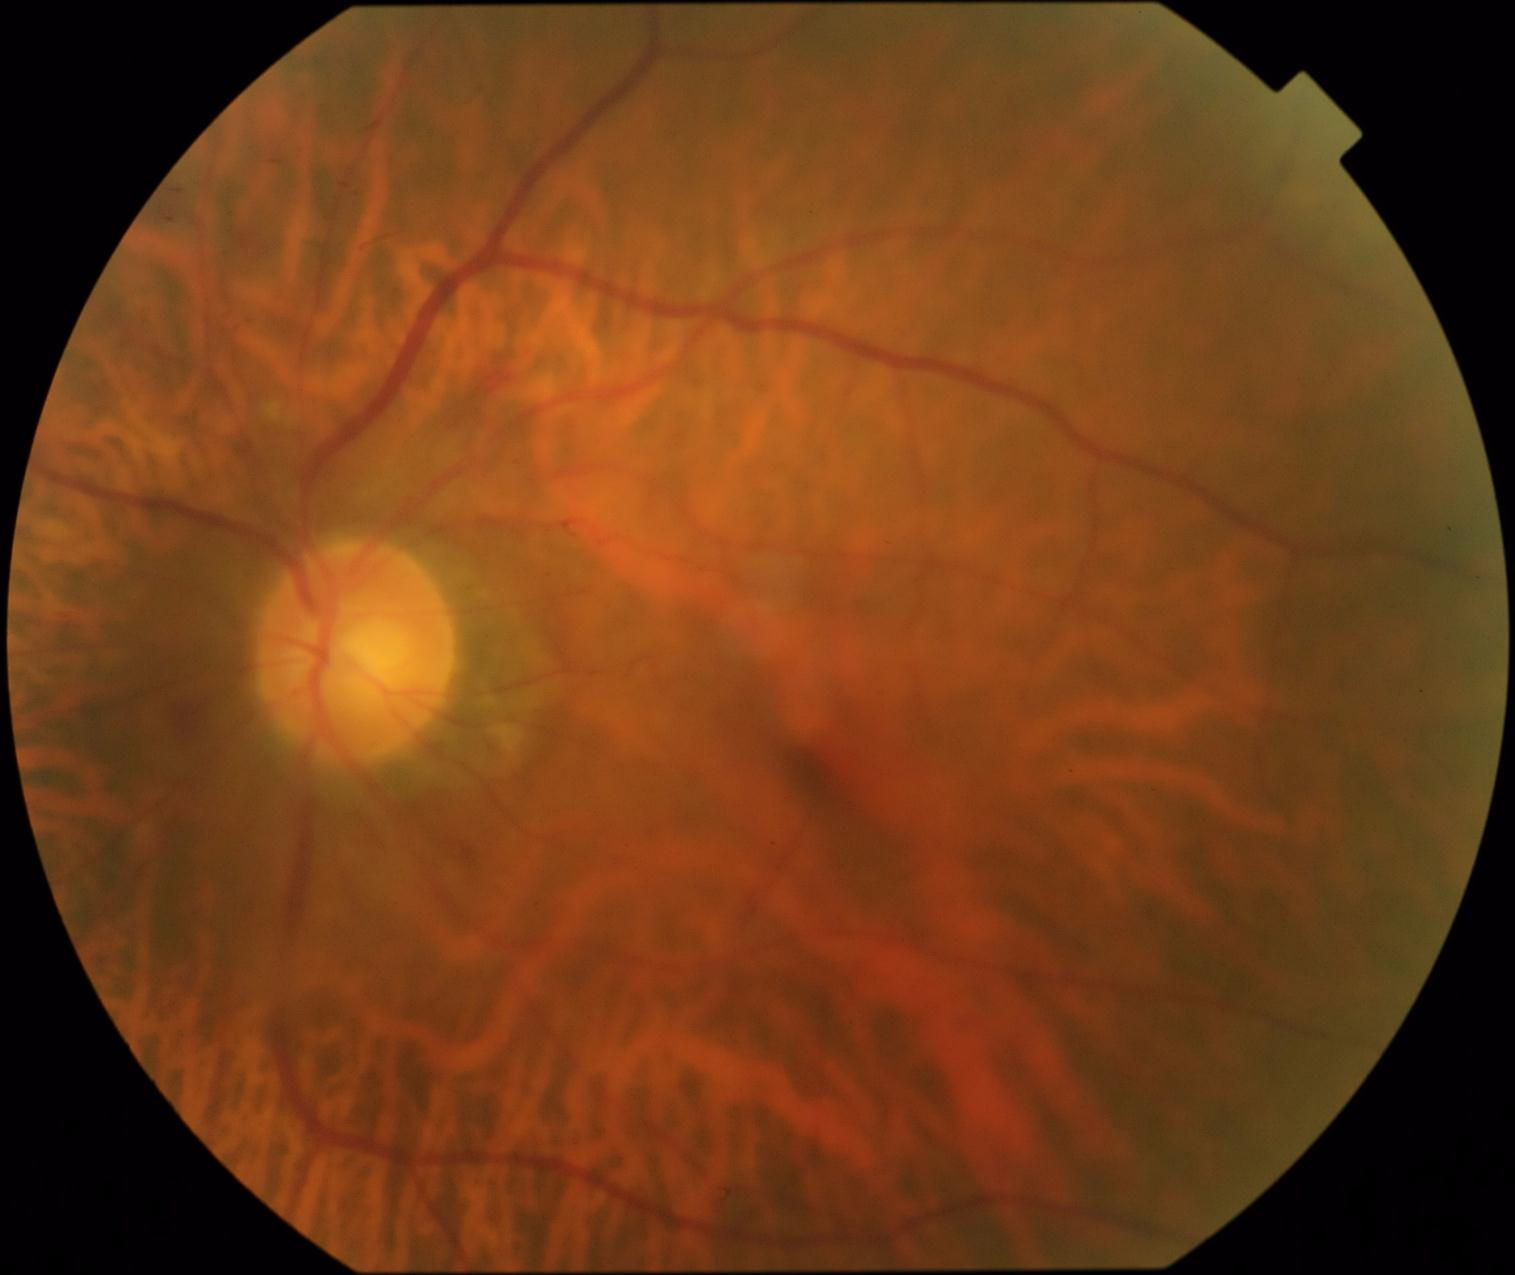
Retinopathy: grade 2 (moderate NPDR).